Color fundus photograph — 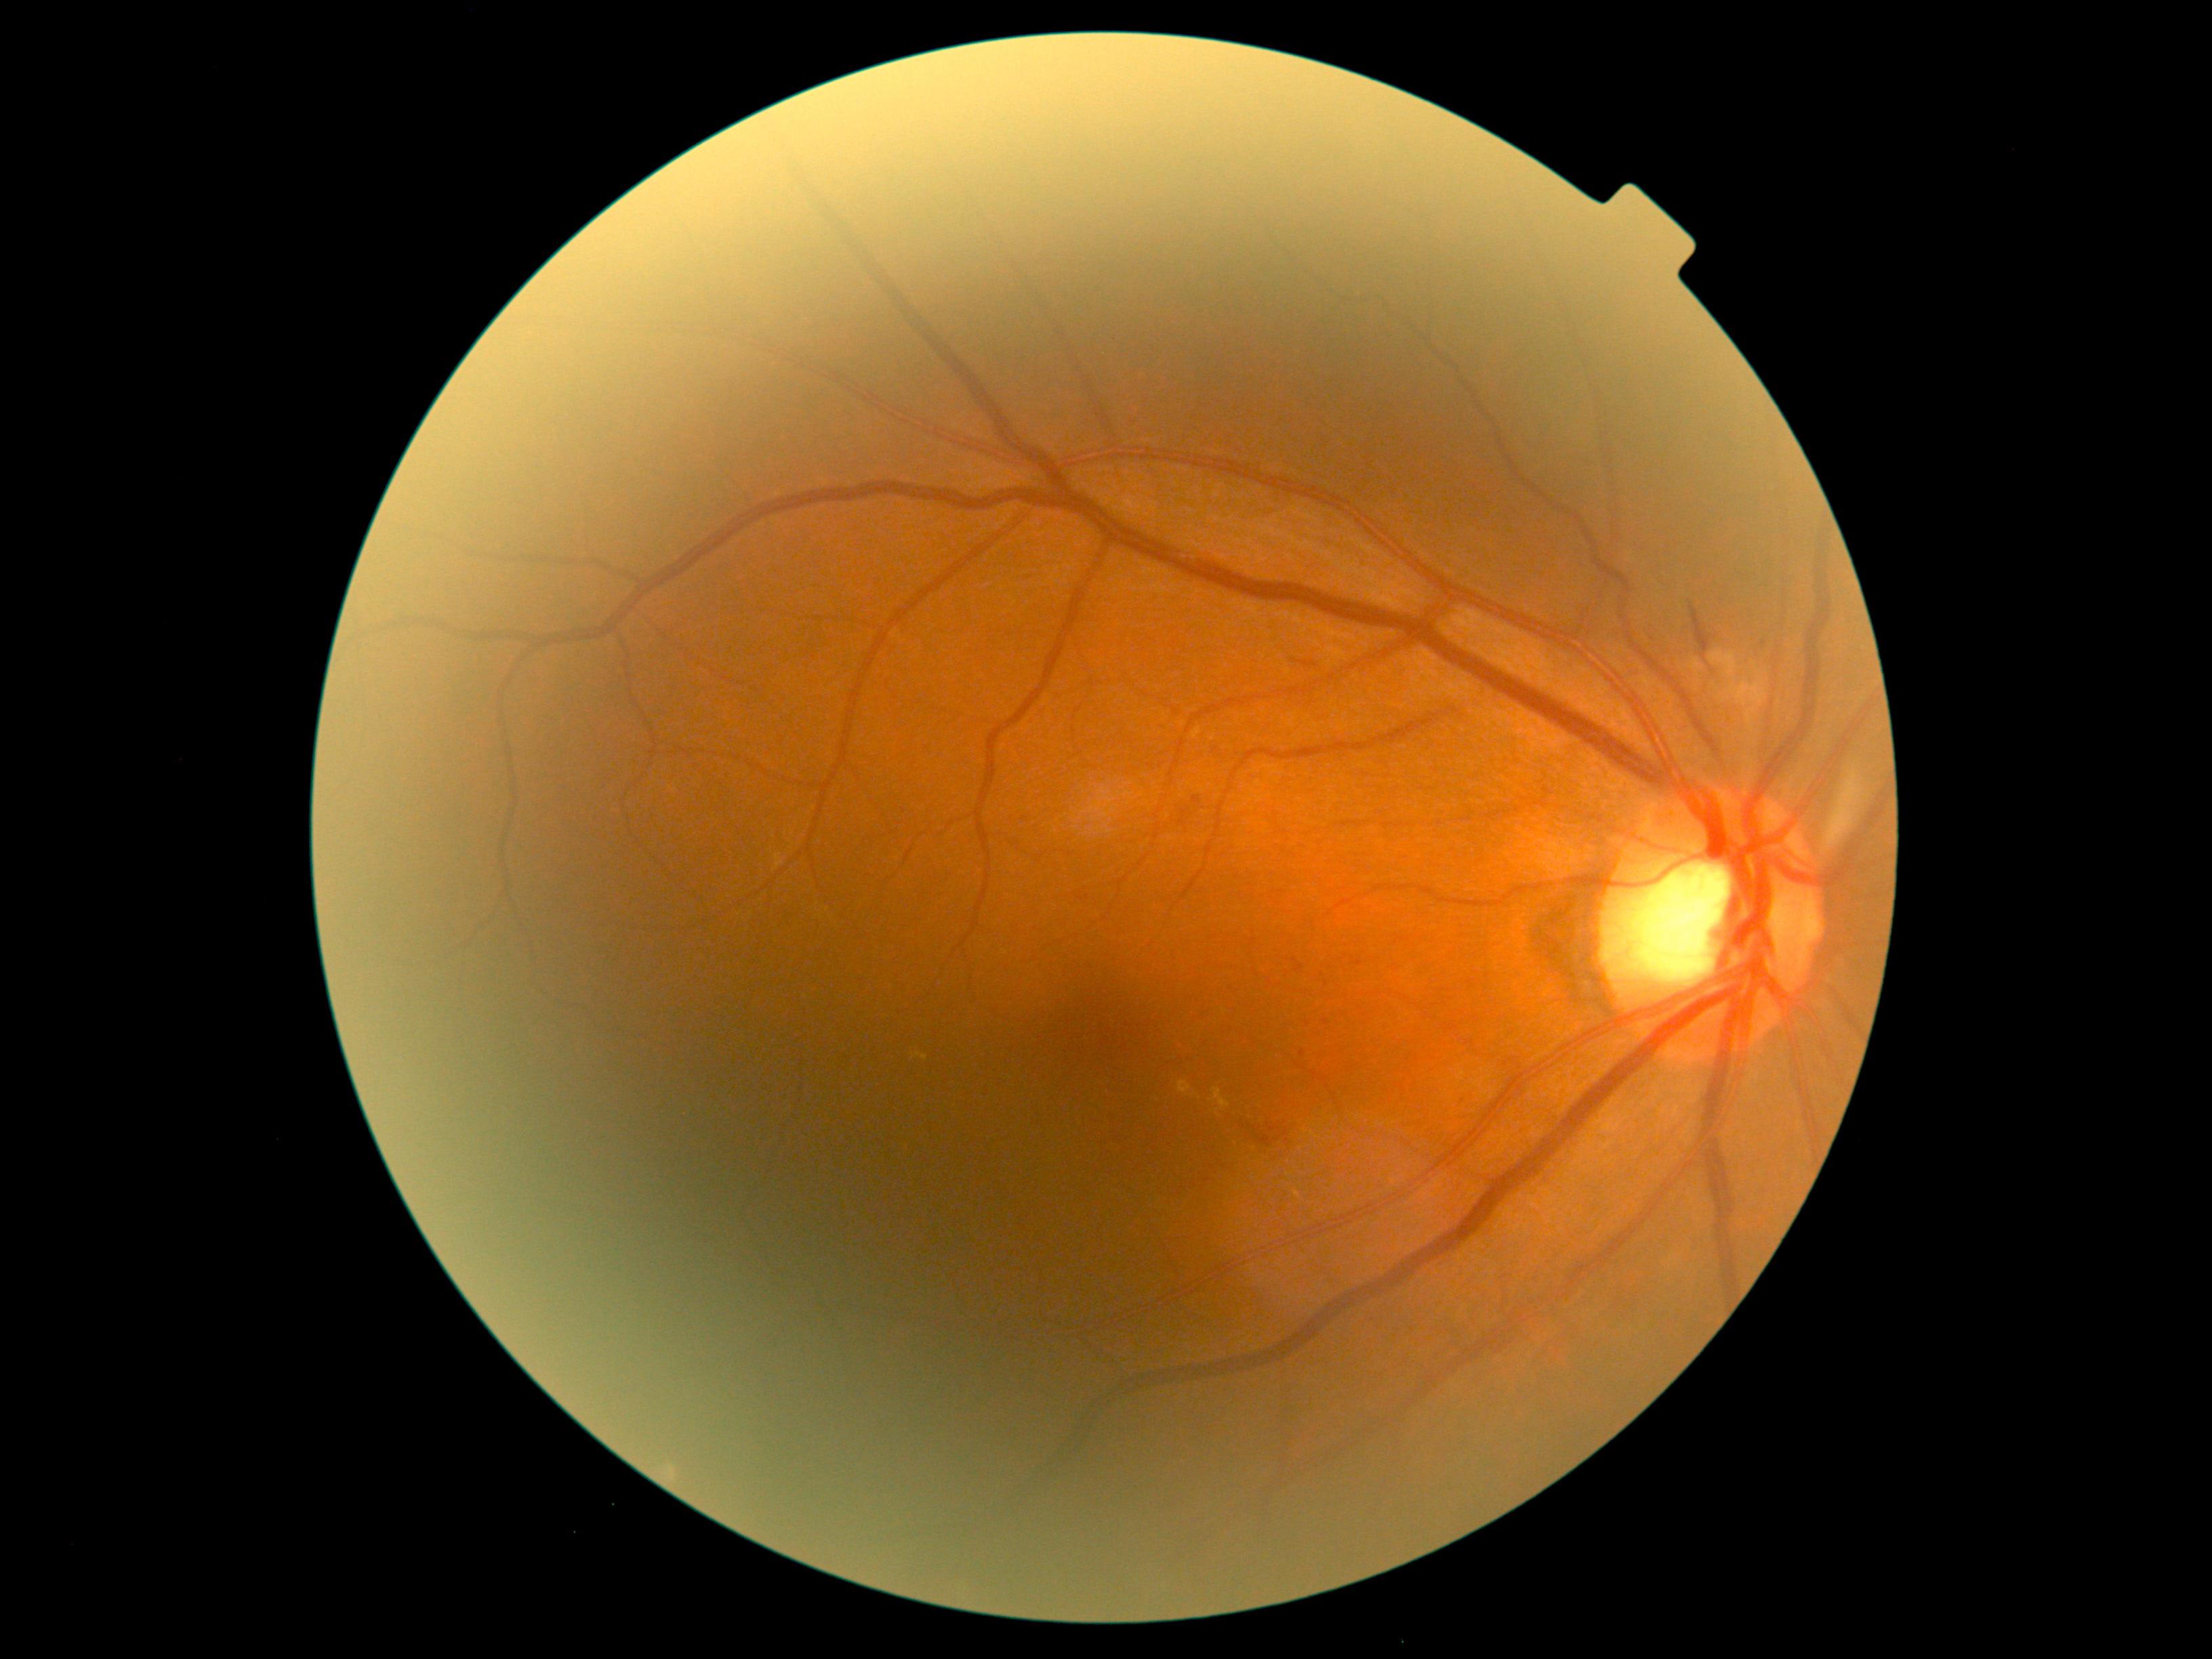

DR stage: 2/4. DR class: non-proliferative diabetic retinopathy.